848 x 848 pixels
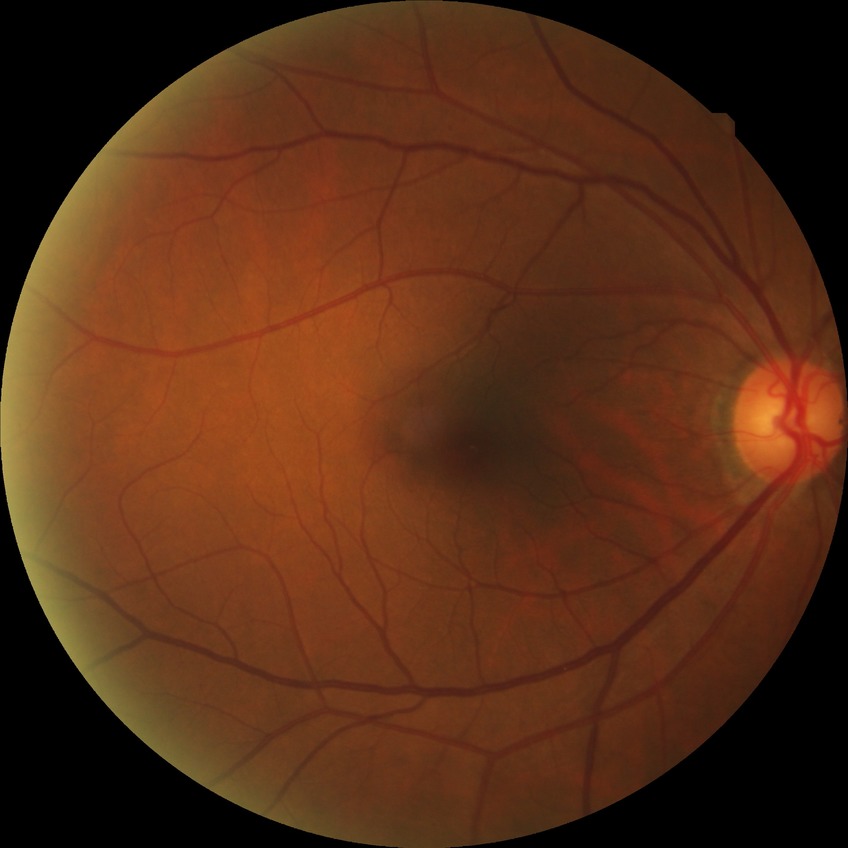 DR impression: no DR findings, Davis DR grade: NDR.